FOV: 45 degrees:
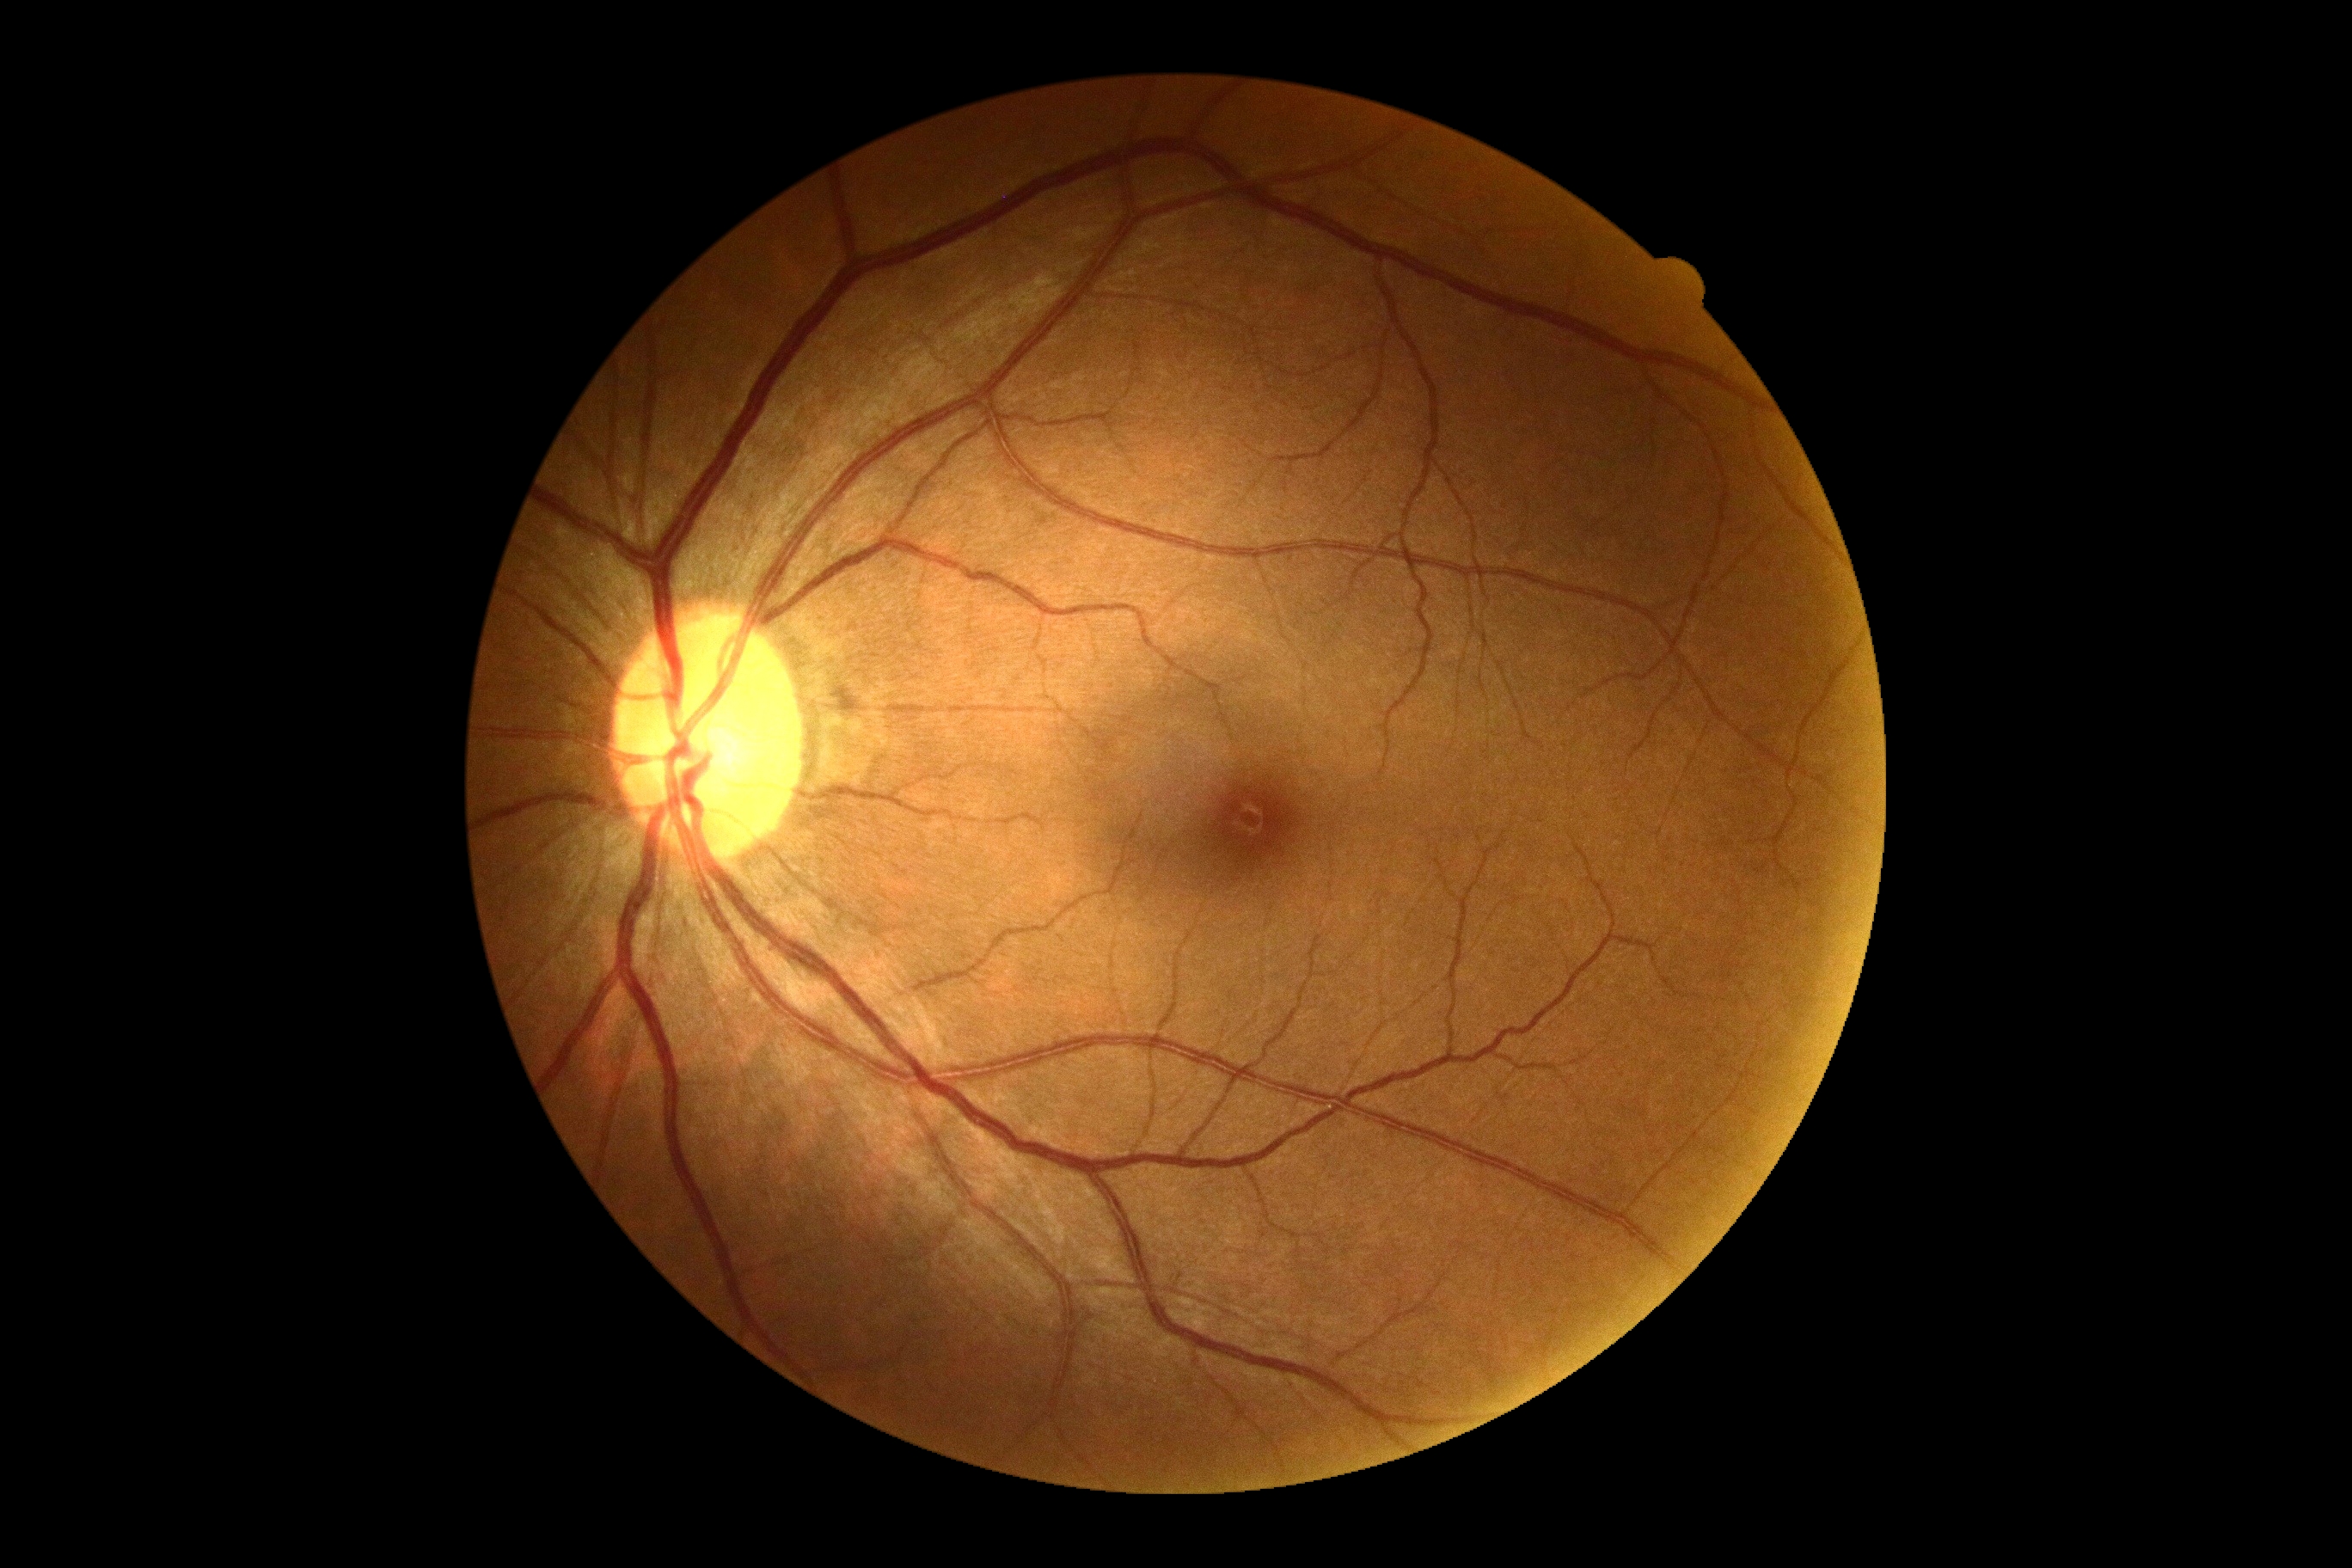
No signs of diabetic retinopathy. DR severity: no apparent retinopathy (grade 0).